1960x1897px, FOV: 45 degrees: 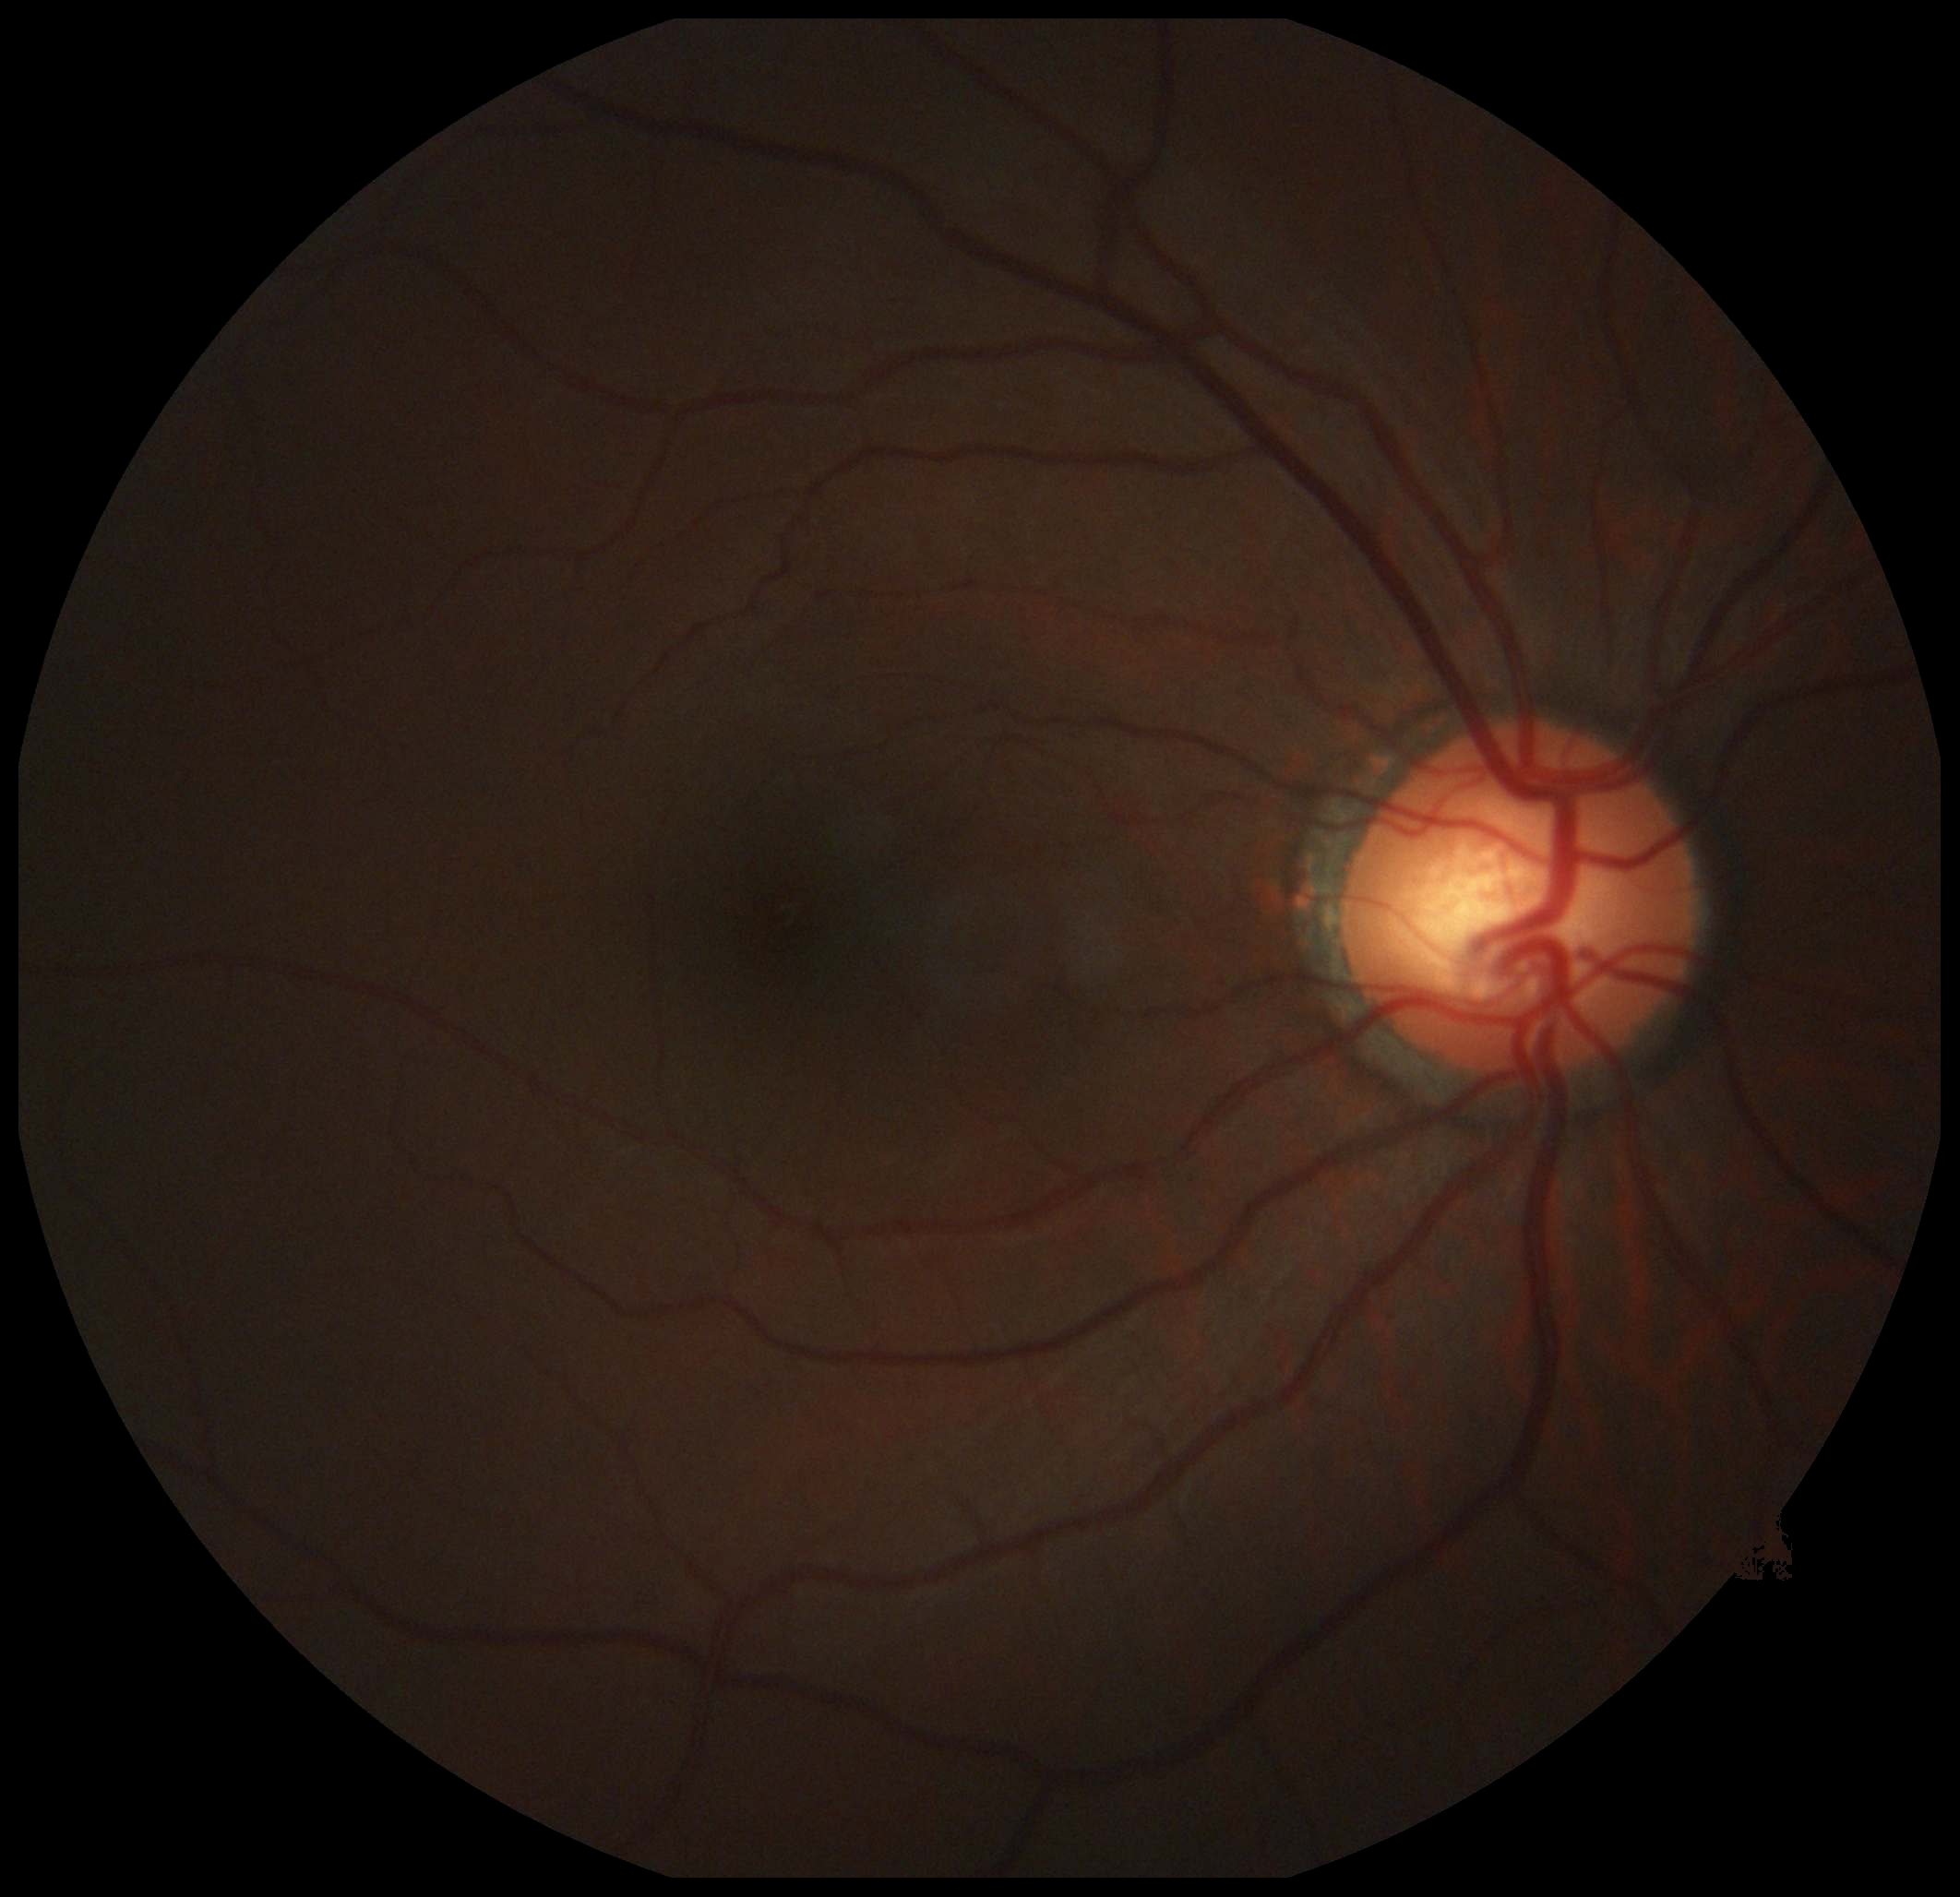 Diabetic retinopathy is grade 0 (no apparent retinopathy). No apparent diabetic retinopathy.